Fundus photo; Davis DR grading; 45 degree fundus photograph.
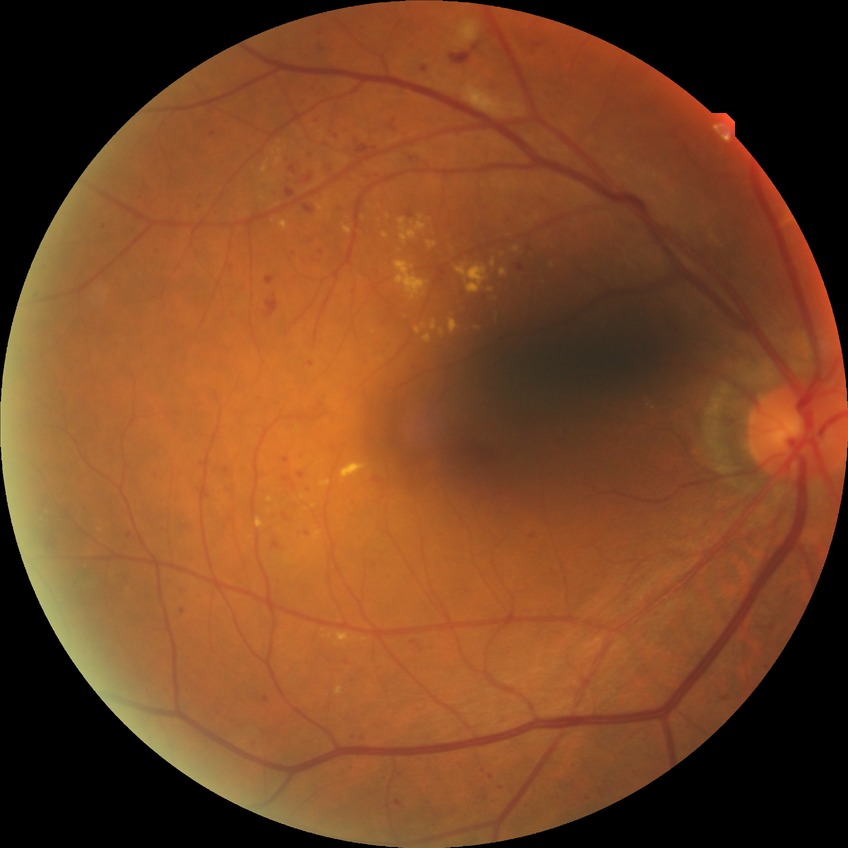
DR class@non-proliferative diabetic retinopathy, modified Davis grading@simple diabetic retinopathy.